Acquired with a NIDEK AFC-230; posterior pole photograph; graded on the modified Davis scale.
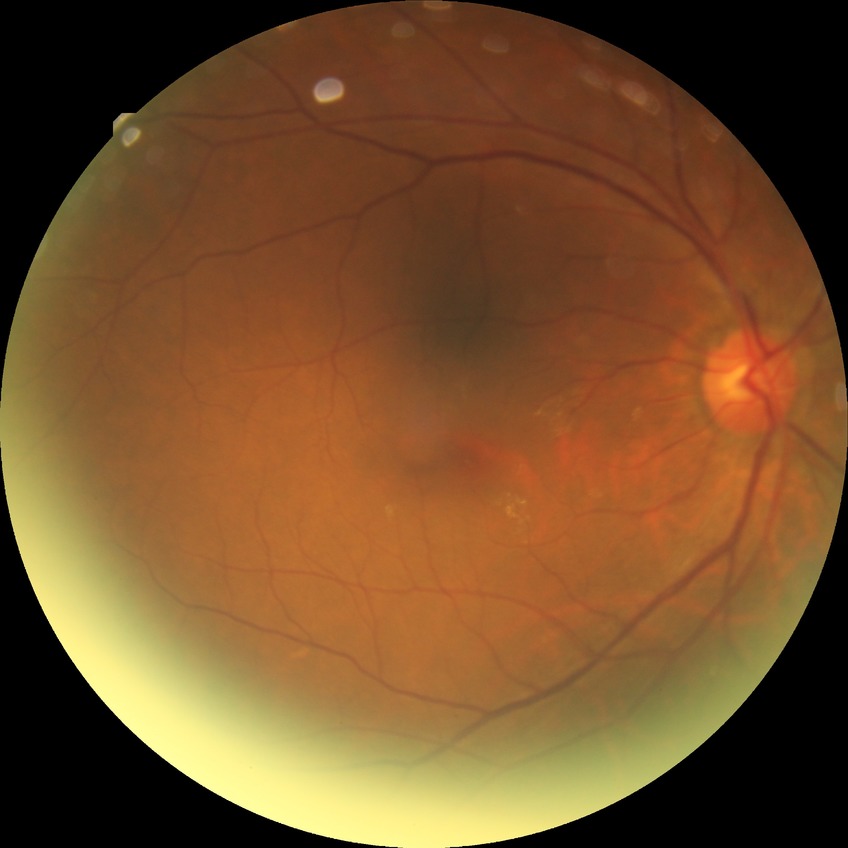 Modified Davis classification: no diabetic retinopathy.